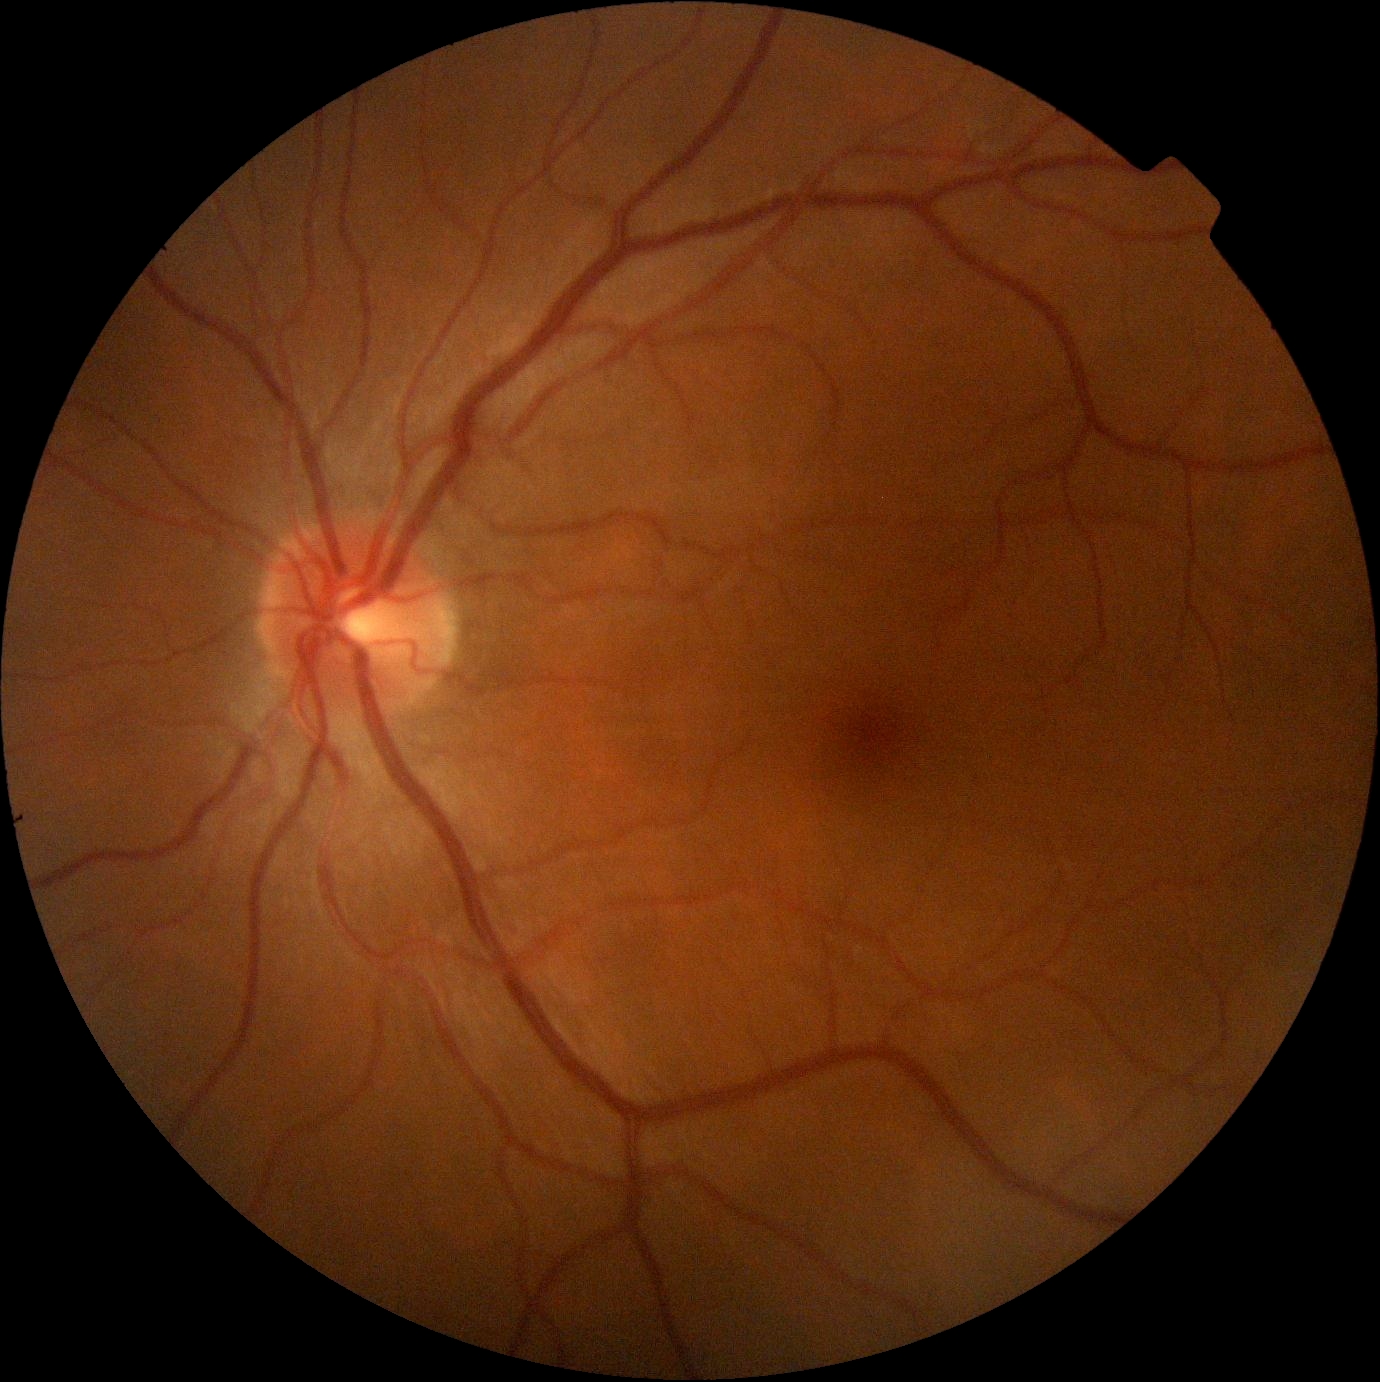 DR severity = 0/4.